2352x1568 · 45° FOV · CFP — 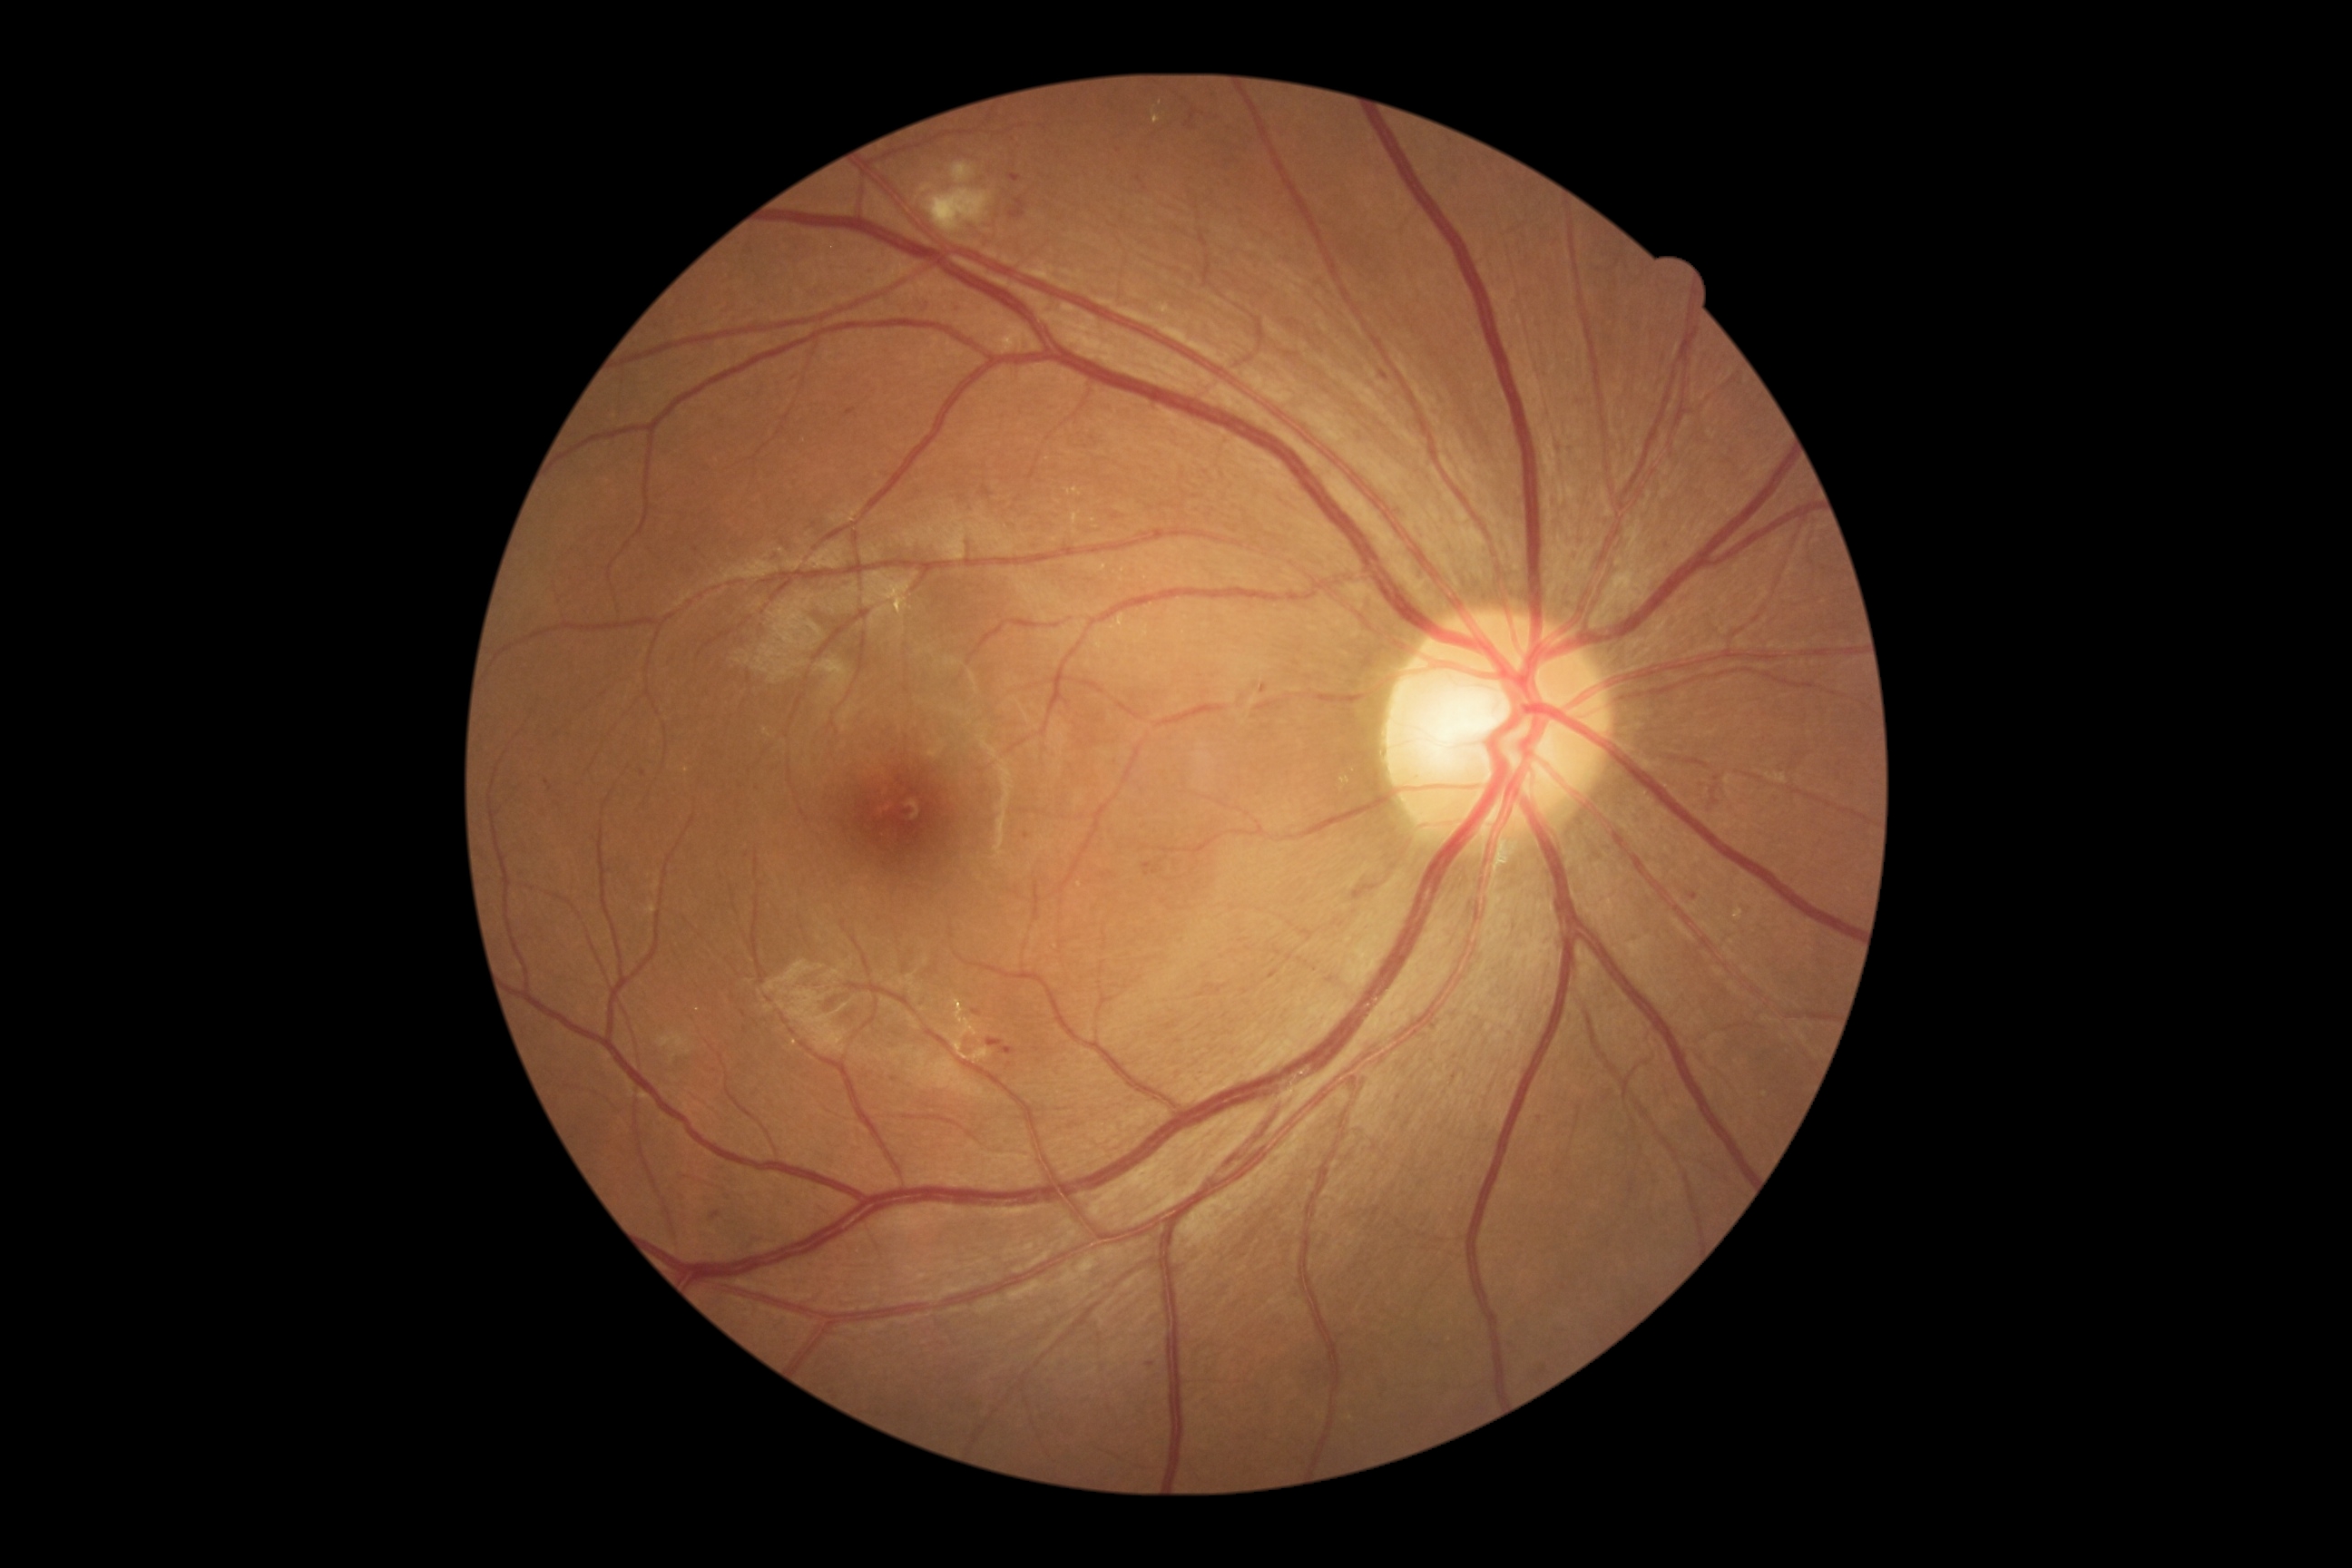

Diabetic retinopathy (DR) is moderate non-proliferative diabetic retinopathy (grade 2)
Representative lesions:
microaneurysms (MAs) (partial): <bbox>1380, 371, 1389, 380</bbox> | <bbox>710, 1211, 721, 1220</bbox> | <bbox>954, 304, 959, 315</bbox> | <bbox>986, 1039, 1017, 1055</bbox> | <bbox>1184, 108, 1200, 130</bbox> | <bbox>1260, 685, 1268, 694</bbox> | <bbox>1142, 863, 1152, 877</bbox> | <bbox>921, 299, 932, 313</bbox> | <bbox>972, 1010, 983, 1017</bbox> | <bbox>642, 770, 647, 778</bbox>
MAs (small, approximate centers) near [1718,778] | [741,787] | [747,856] | [1456,1057]
soft exudates (SEs): <bbox>952, 162, 975, 184</bbox> | <bbox>917, 184, 934, 199</bbox> | <bbox>925, 188, 994, 233</bbox>
hemorrhages (HEs): none detected
hard exudates (EXs) (partial): <bbox>885, 591, 906, 607</bbox> | <bbox>1142, 627, 1150, 640</bbox> | <bbox>945, 999, 992, 1064</bbox> | <bbox>640, 1092, 652, 1102</bbox> | <bbox>1066, 489, 1081, 496</bbox> | <bbox>1072, 513, 1081, 525</bbox> | <bbox>1767, 774, 1787, 783</bbox>
EXs (small, approximate centers) near [1094,522] | [1076,533] | [688,770] | [698,1010] | [1124,571]